45-degree field of view · CFP · 2212x1659px.
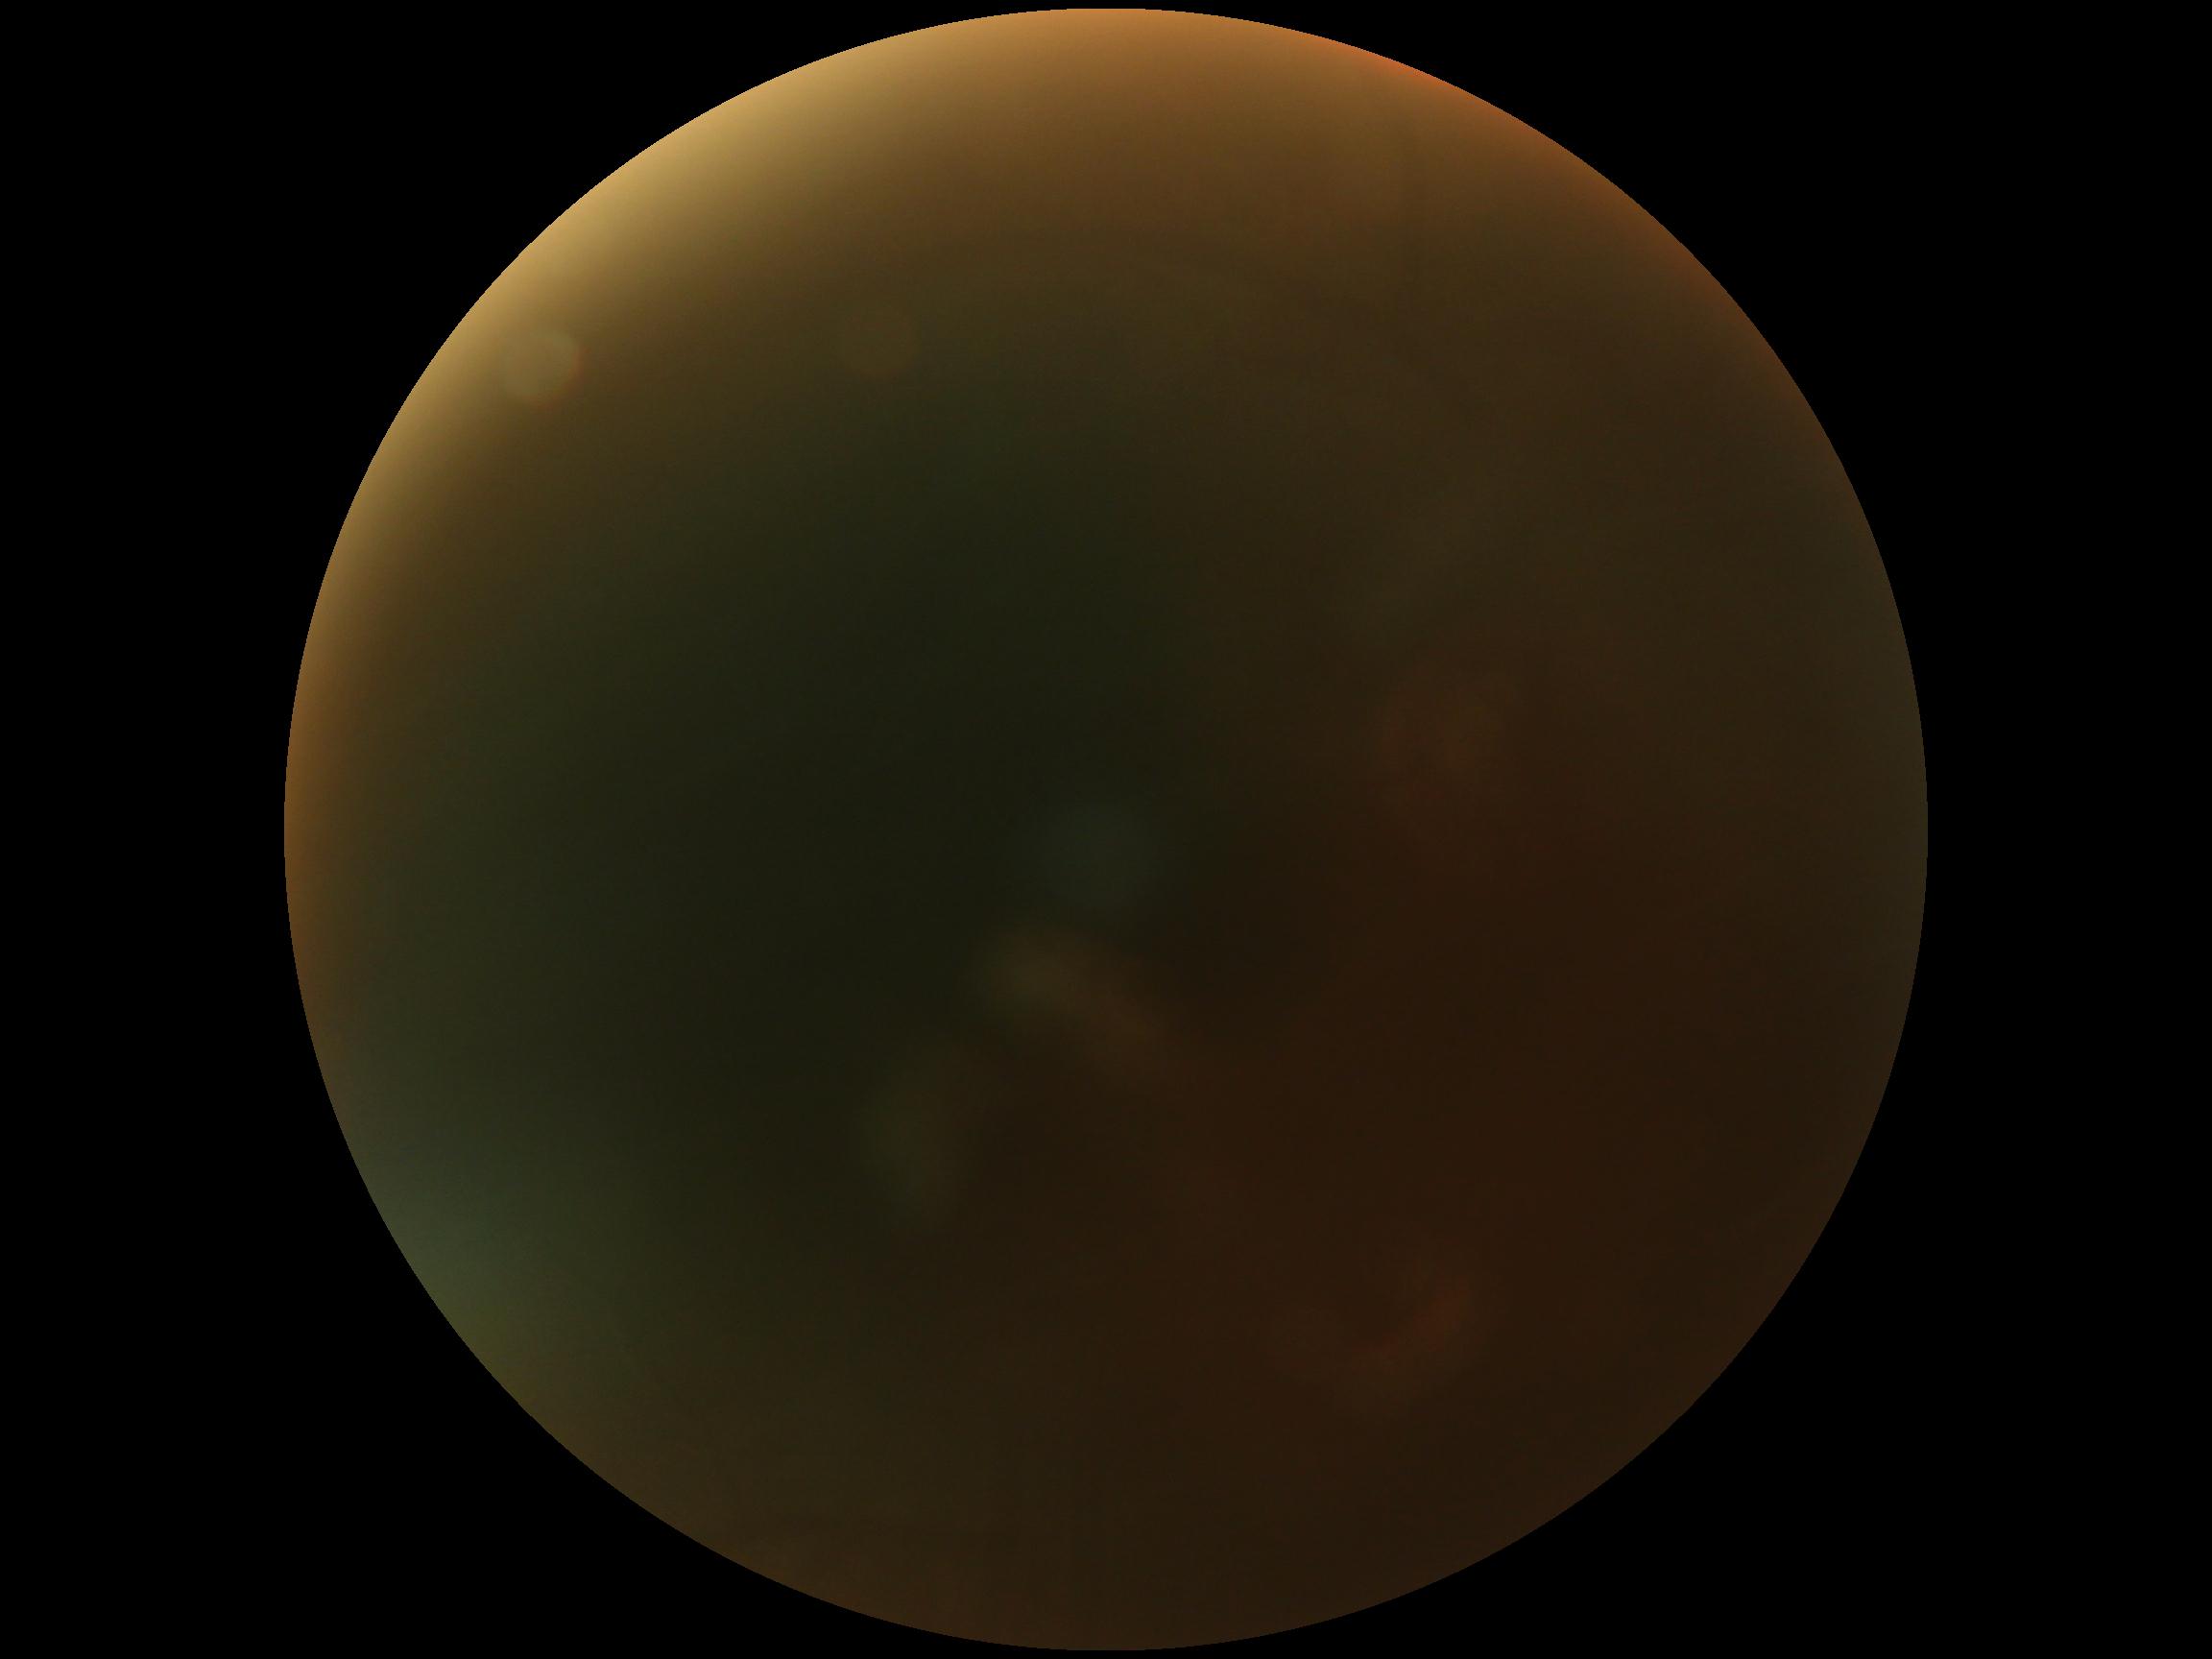
image quality=too poor for DR grading; DR stage=ungradable due to poor image quality.